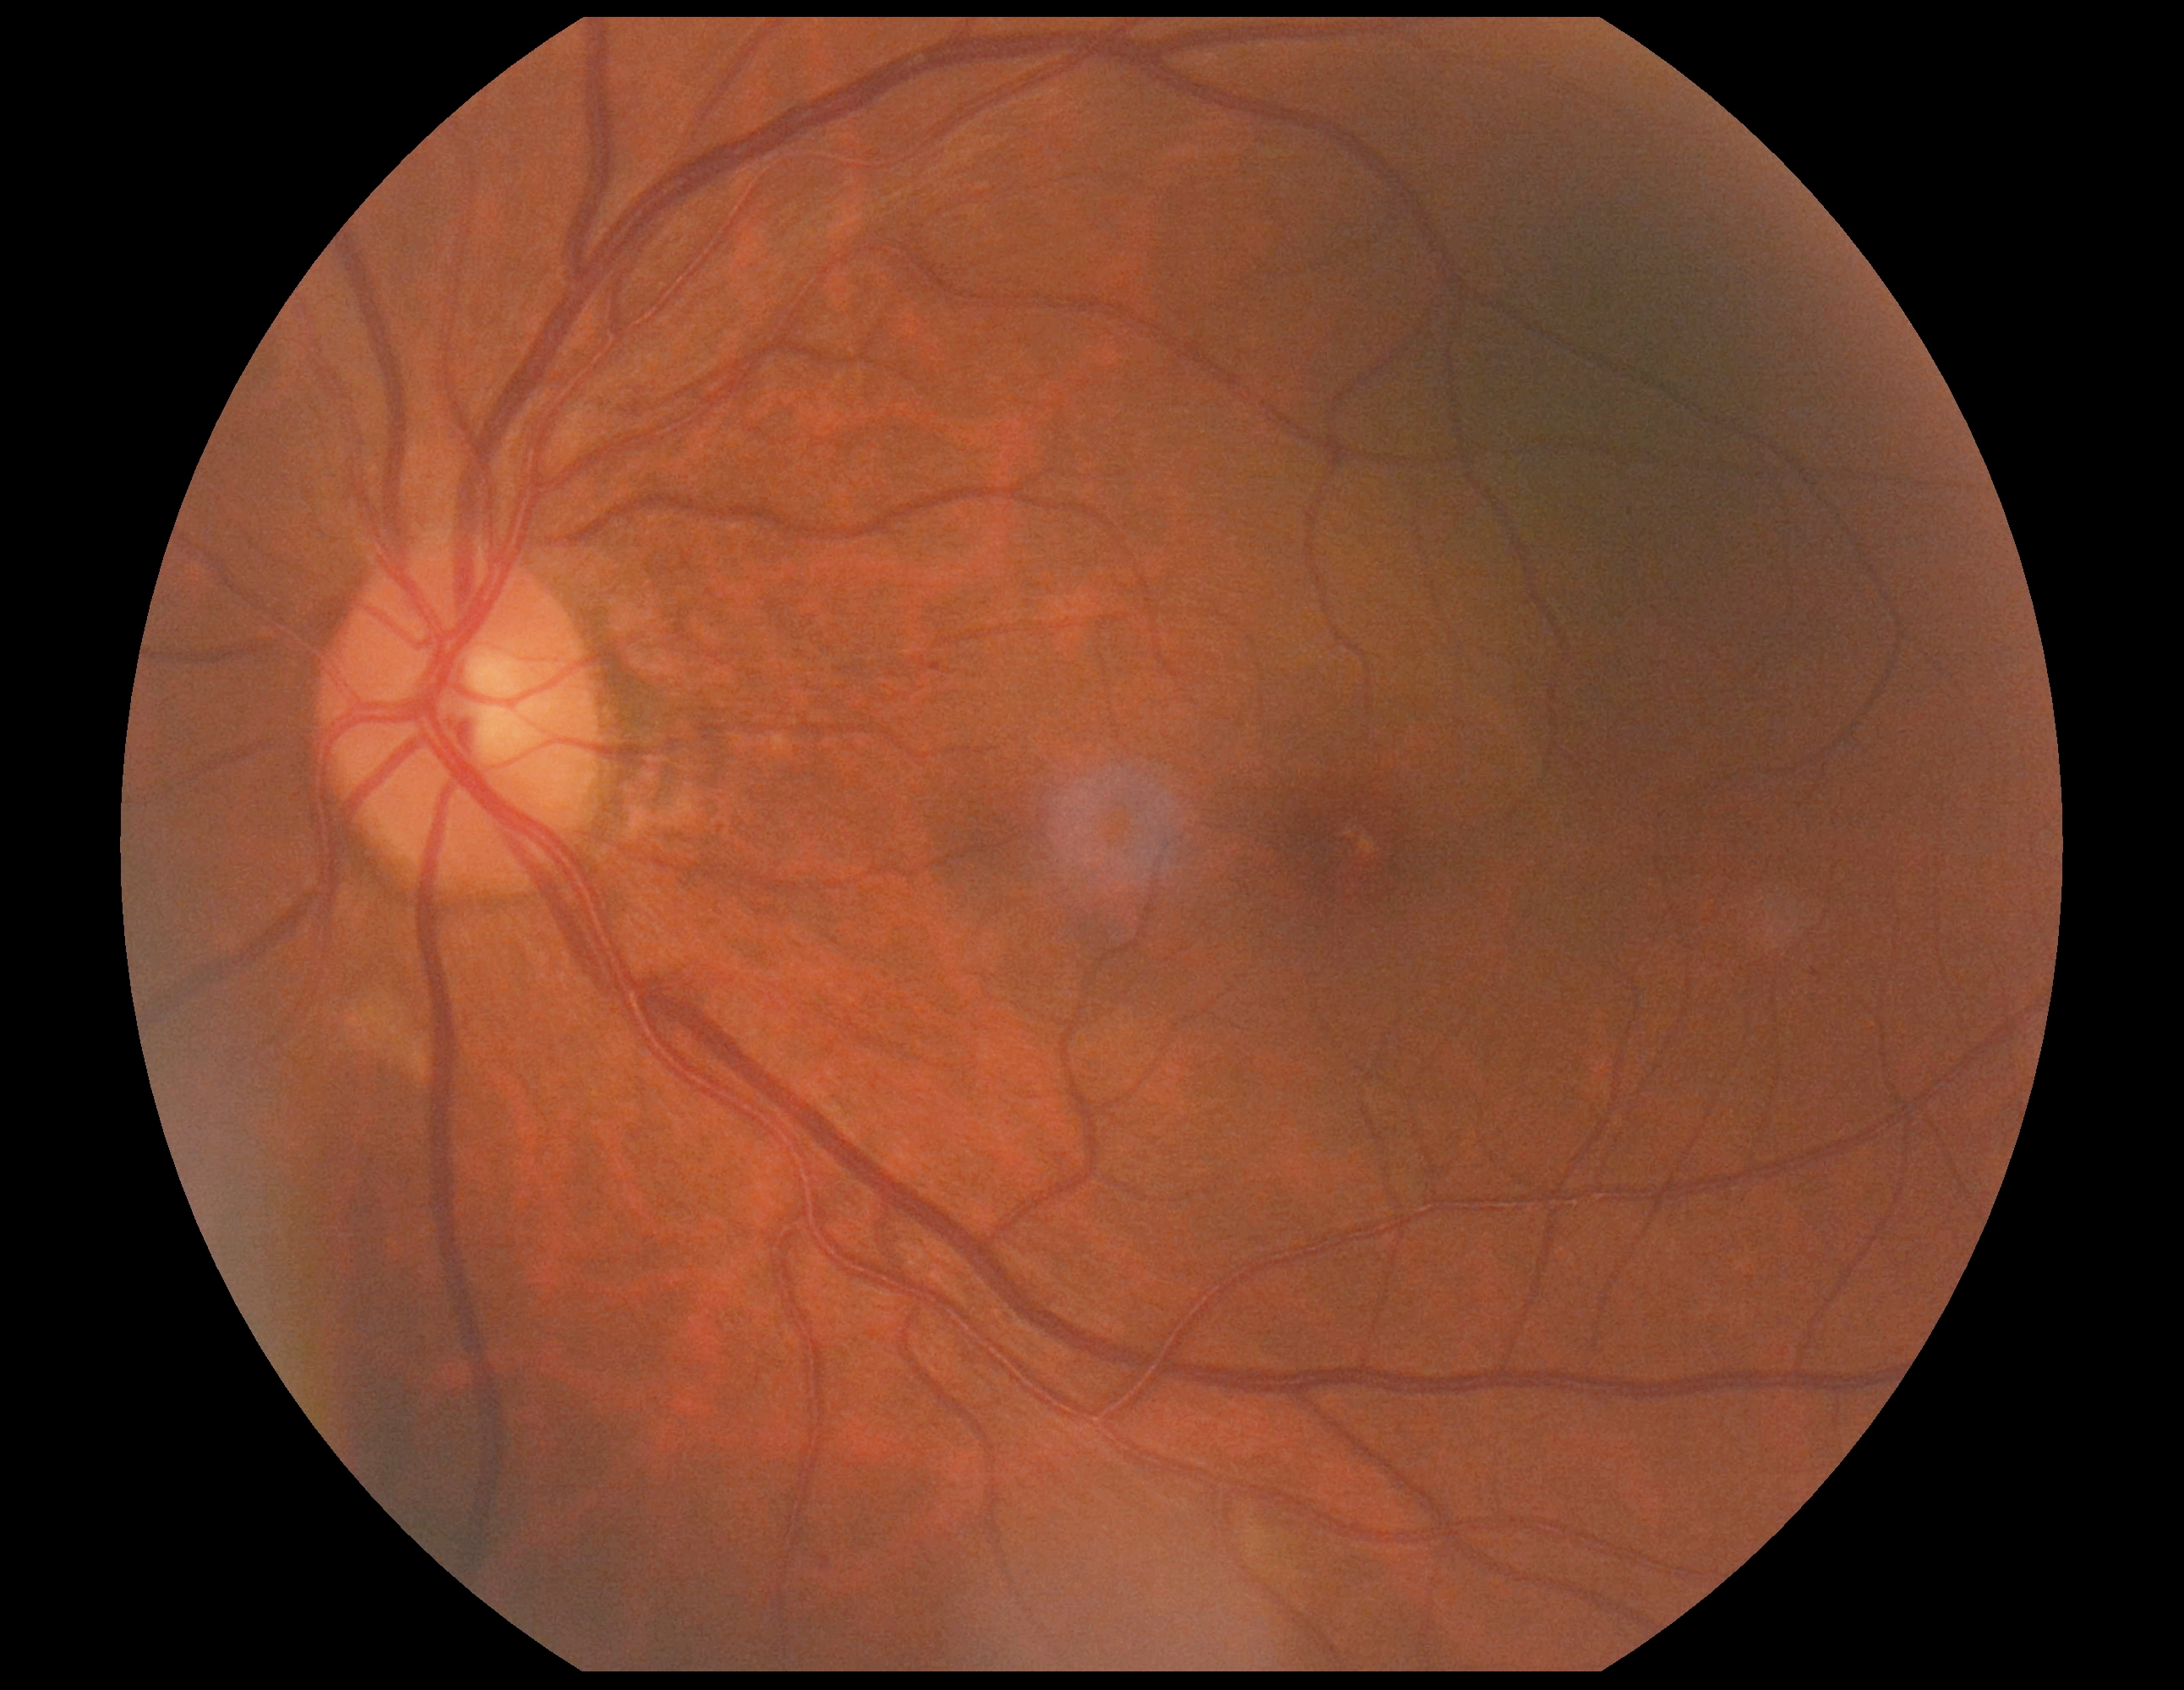
Diabetic retinopathy (DR): 2/4.